NIDEK AFC-230. 848x848px: 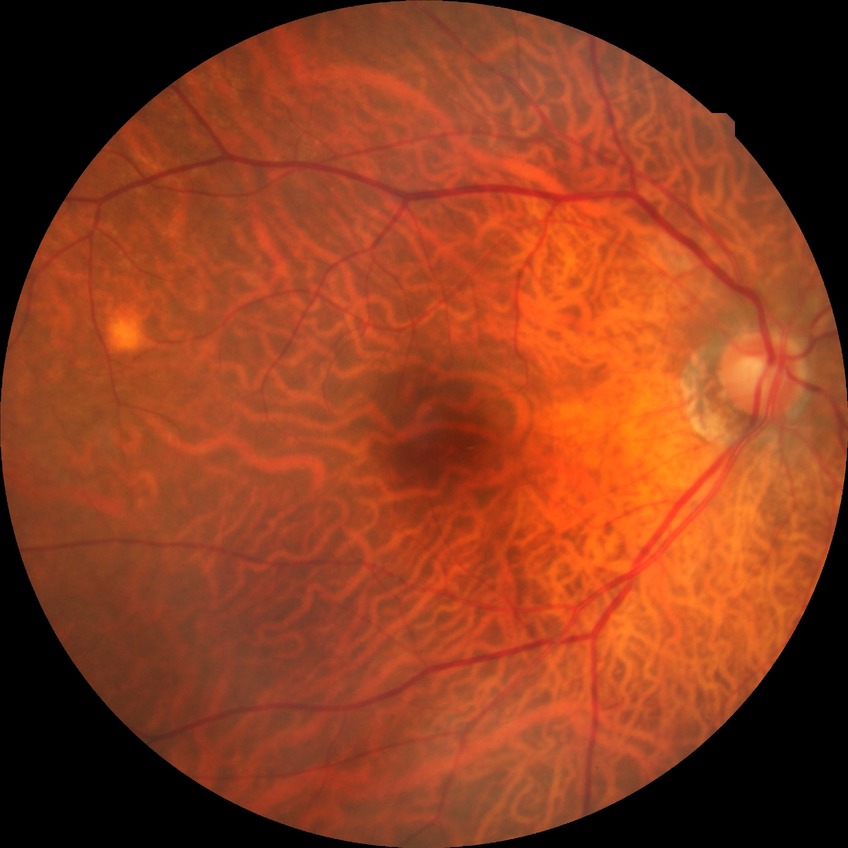 DR severity: NDR; DR impression: no apparent DR.